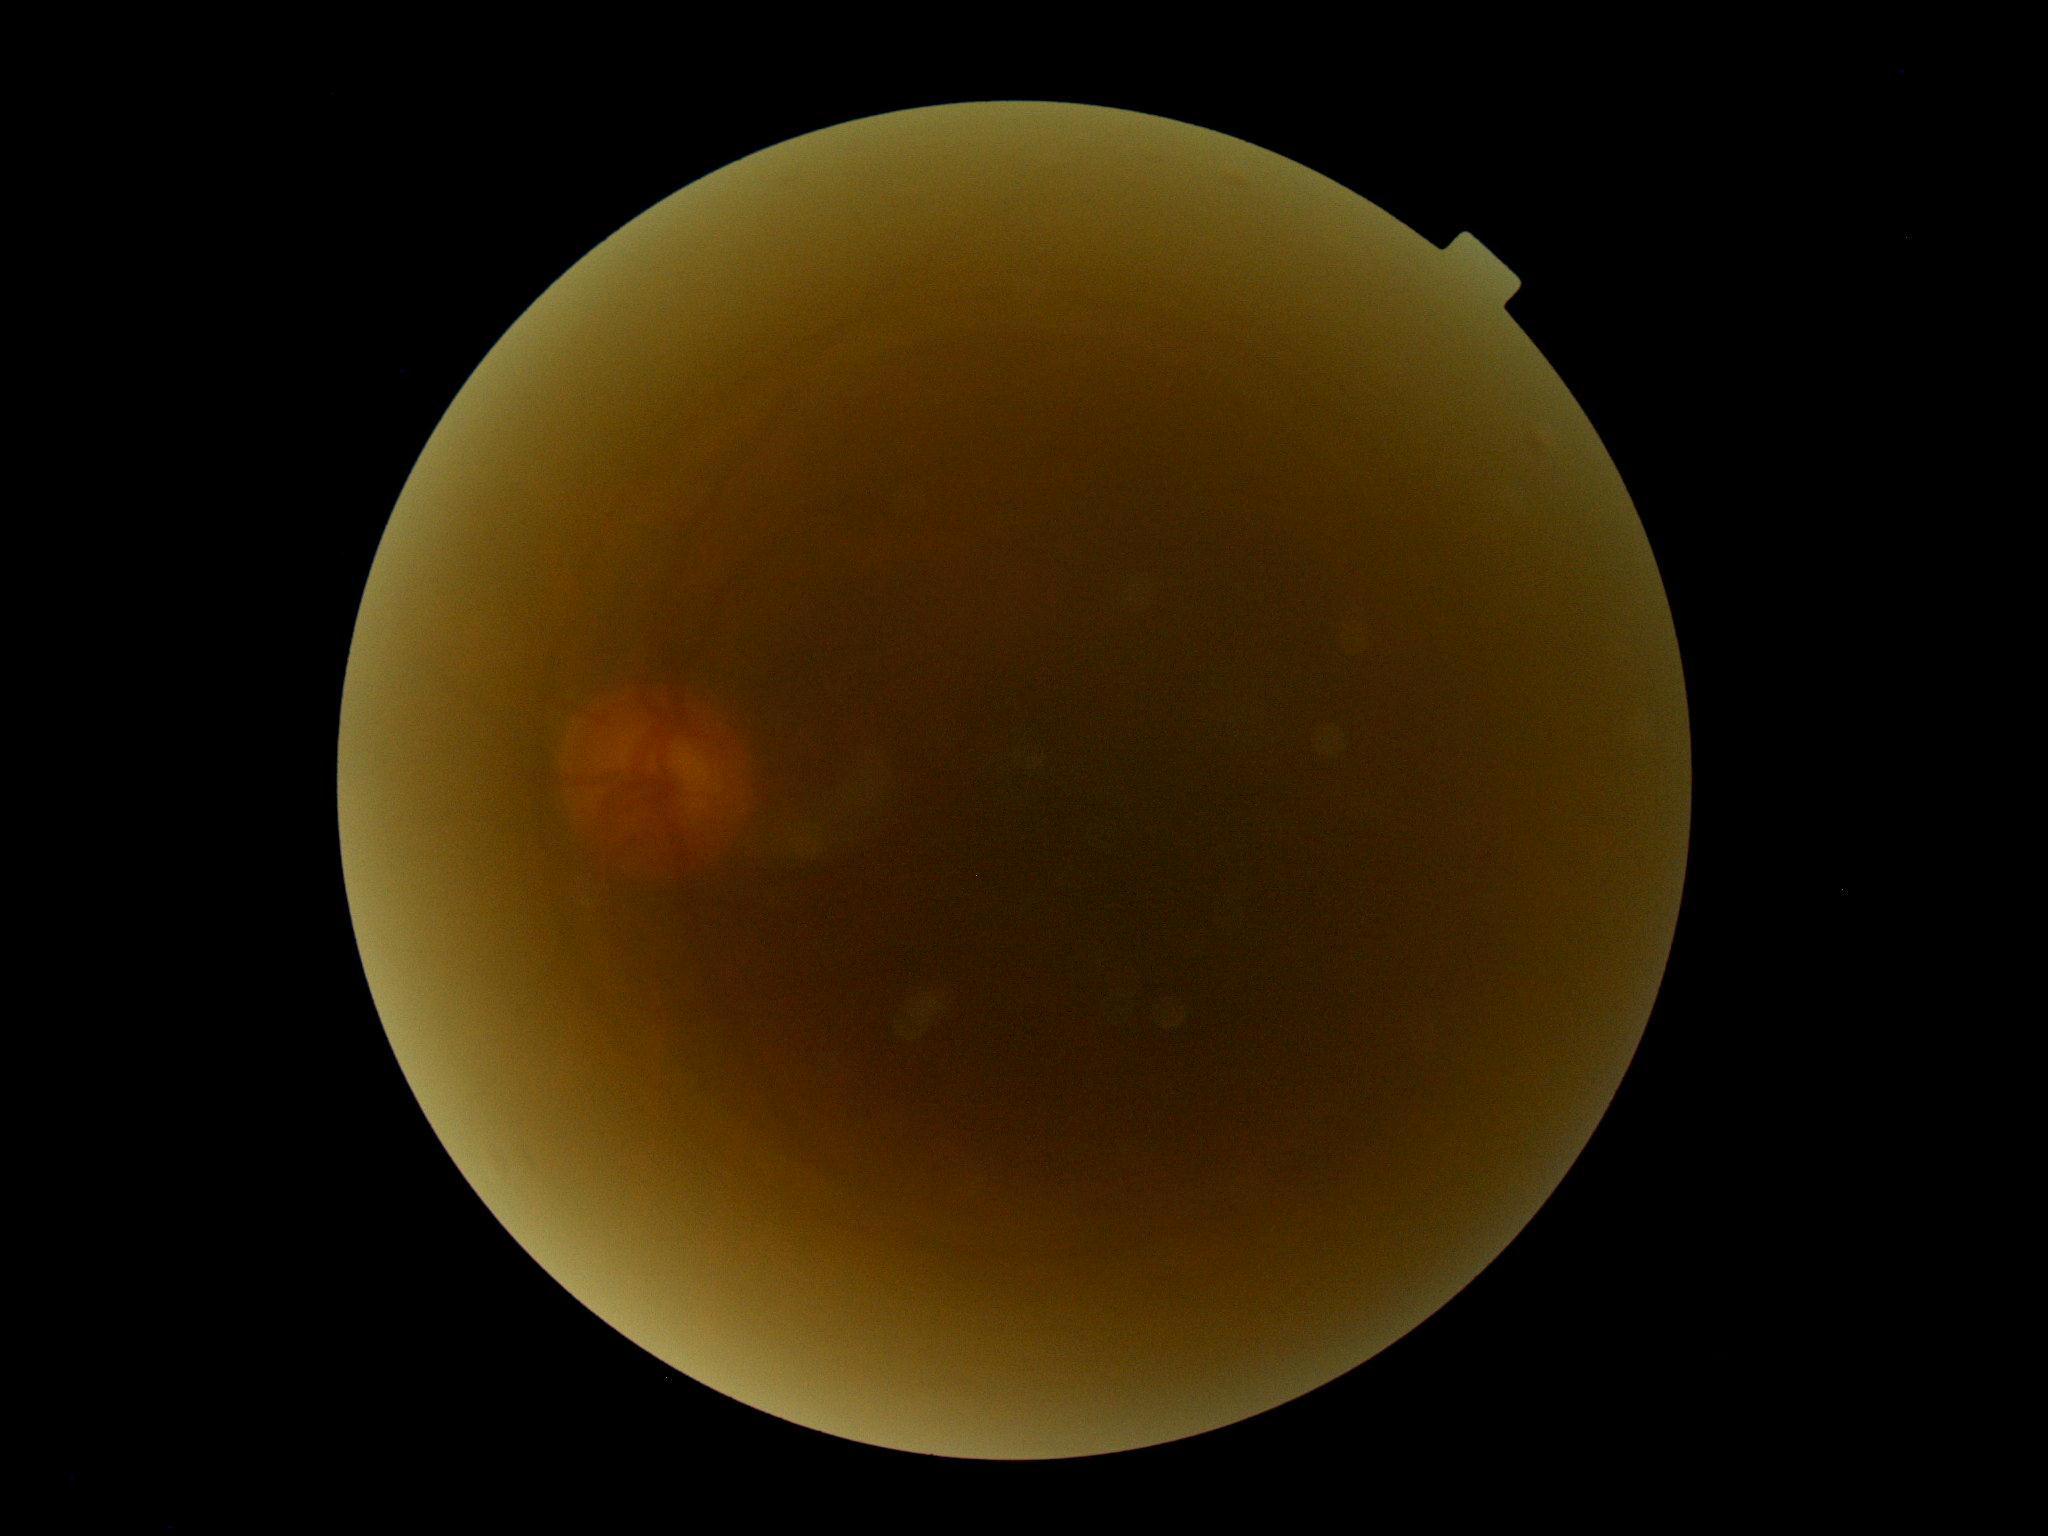
DR severity: ungradable due to poor image quality.